Disc-centered fundus crop:
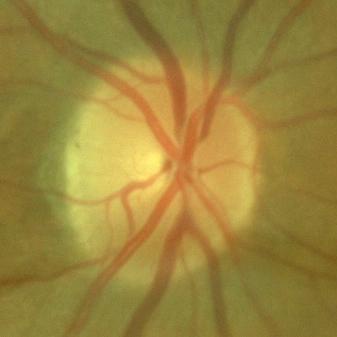 Glaucoma status = no glaucomatous damage.